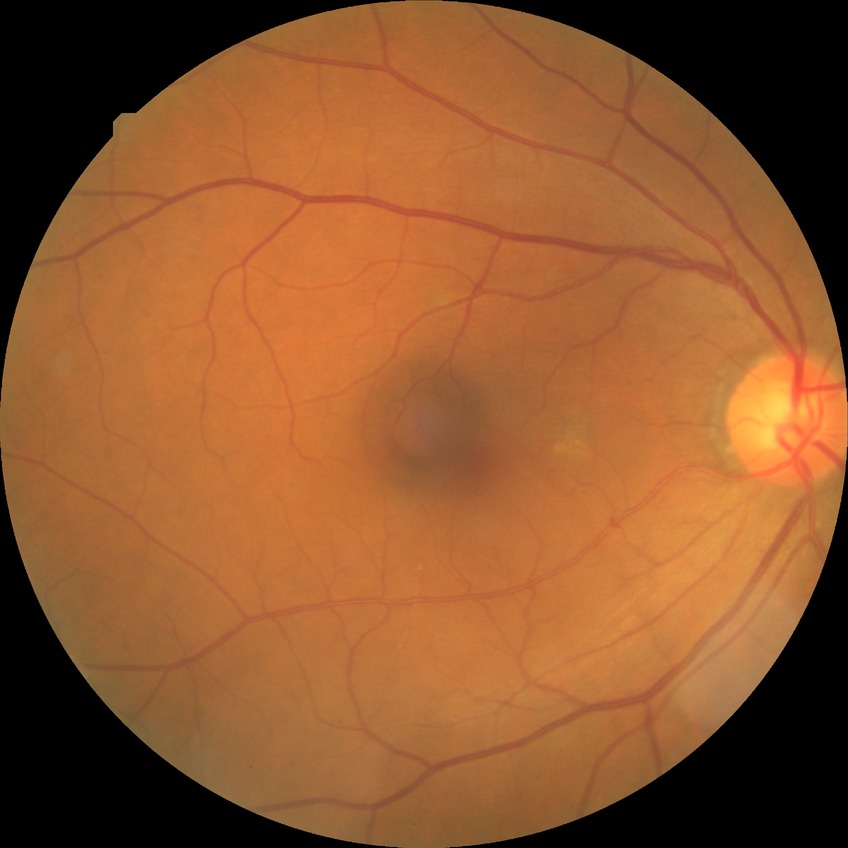
retinopathy stage@no diabetic retinopathy.